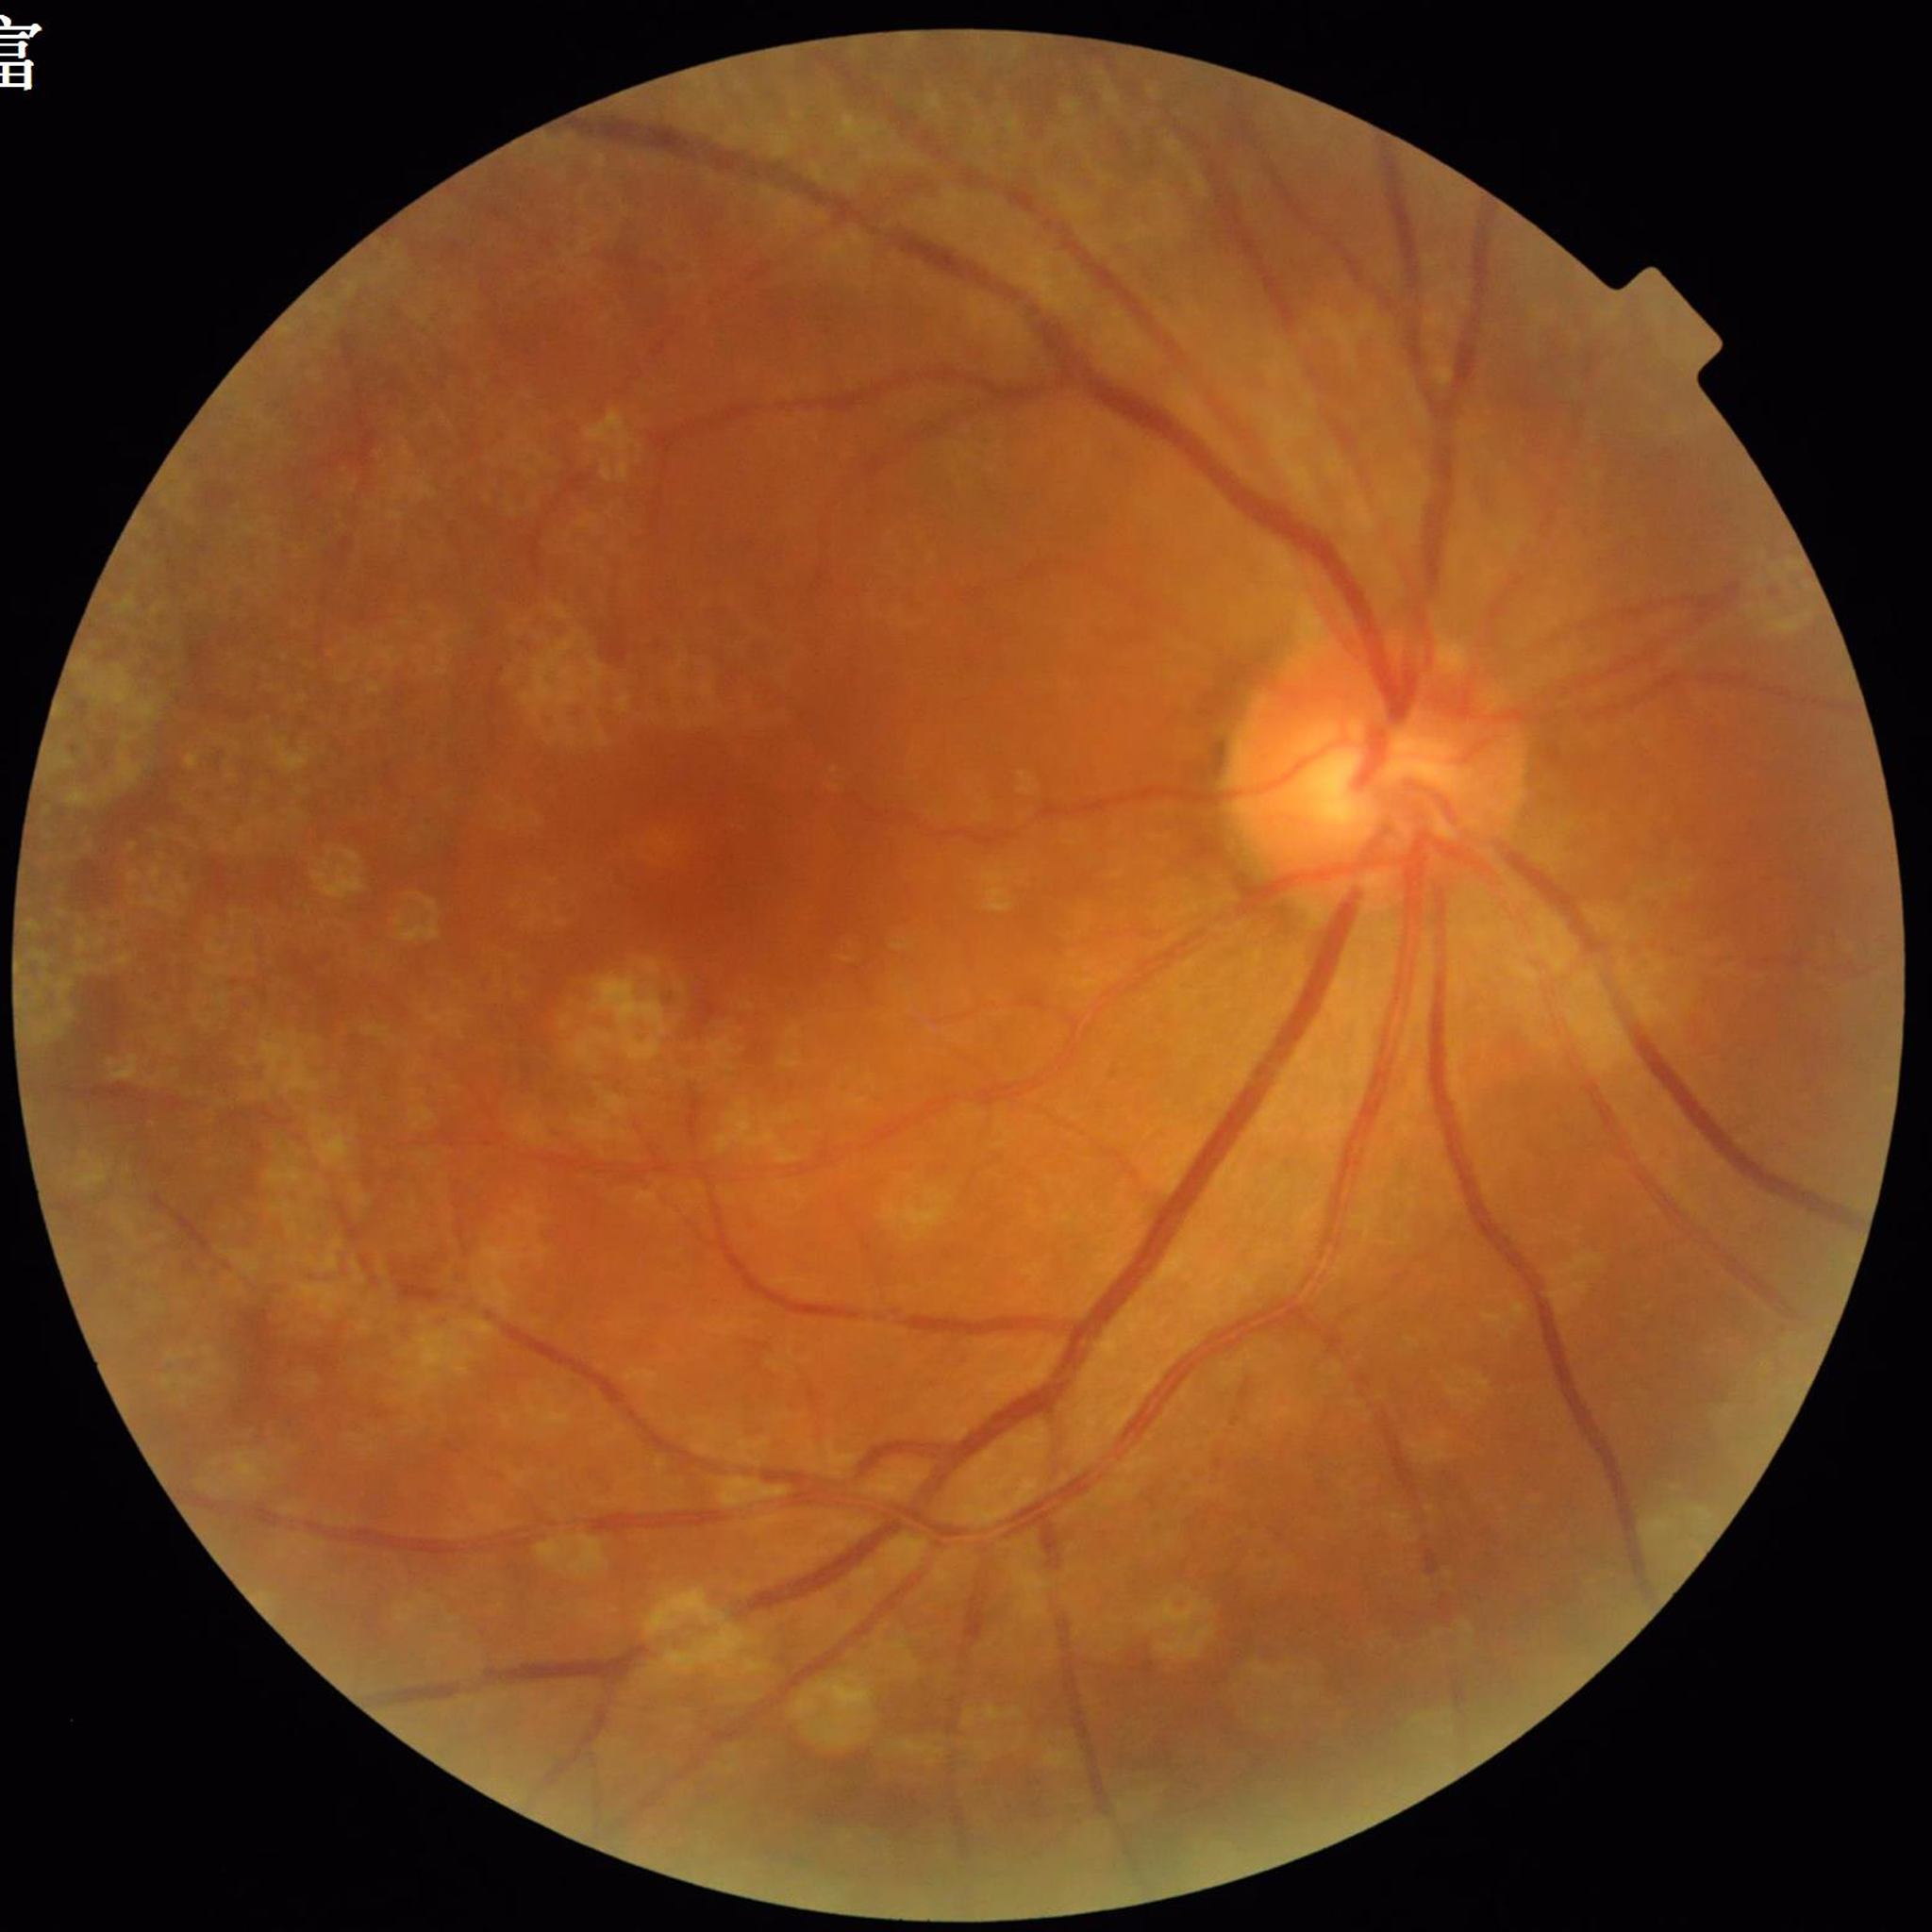 Color fundus photograph from a patient diagnosed with age-related macular degeneration.